ONH-centered crop from a color fundus image:
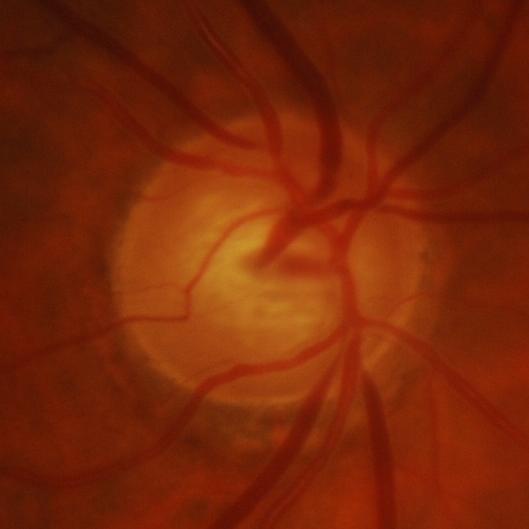
Optic disc appearance consistent with glaucomatous optic neuropathy.